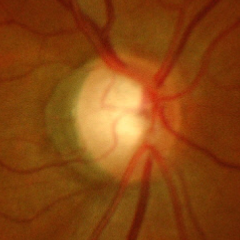

Showing advanced glaucomatous optic neuropathy. Diagnostic criteria: near-total cupping of the optic nerve head, with or without severe visual field loss within the central 10 degrees of fixation.